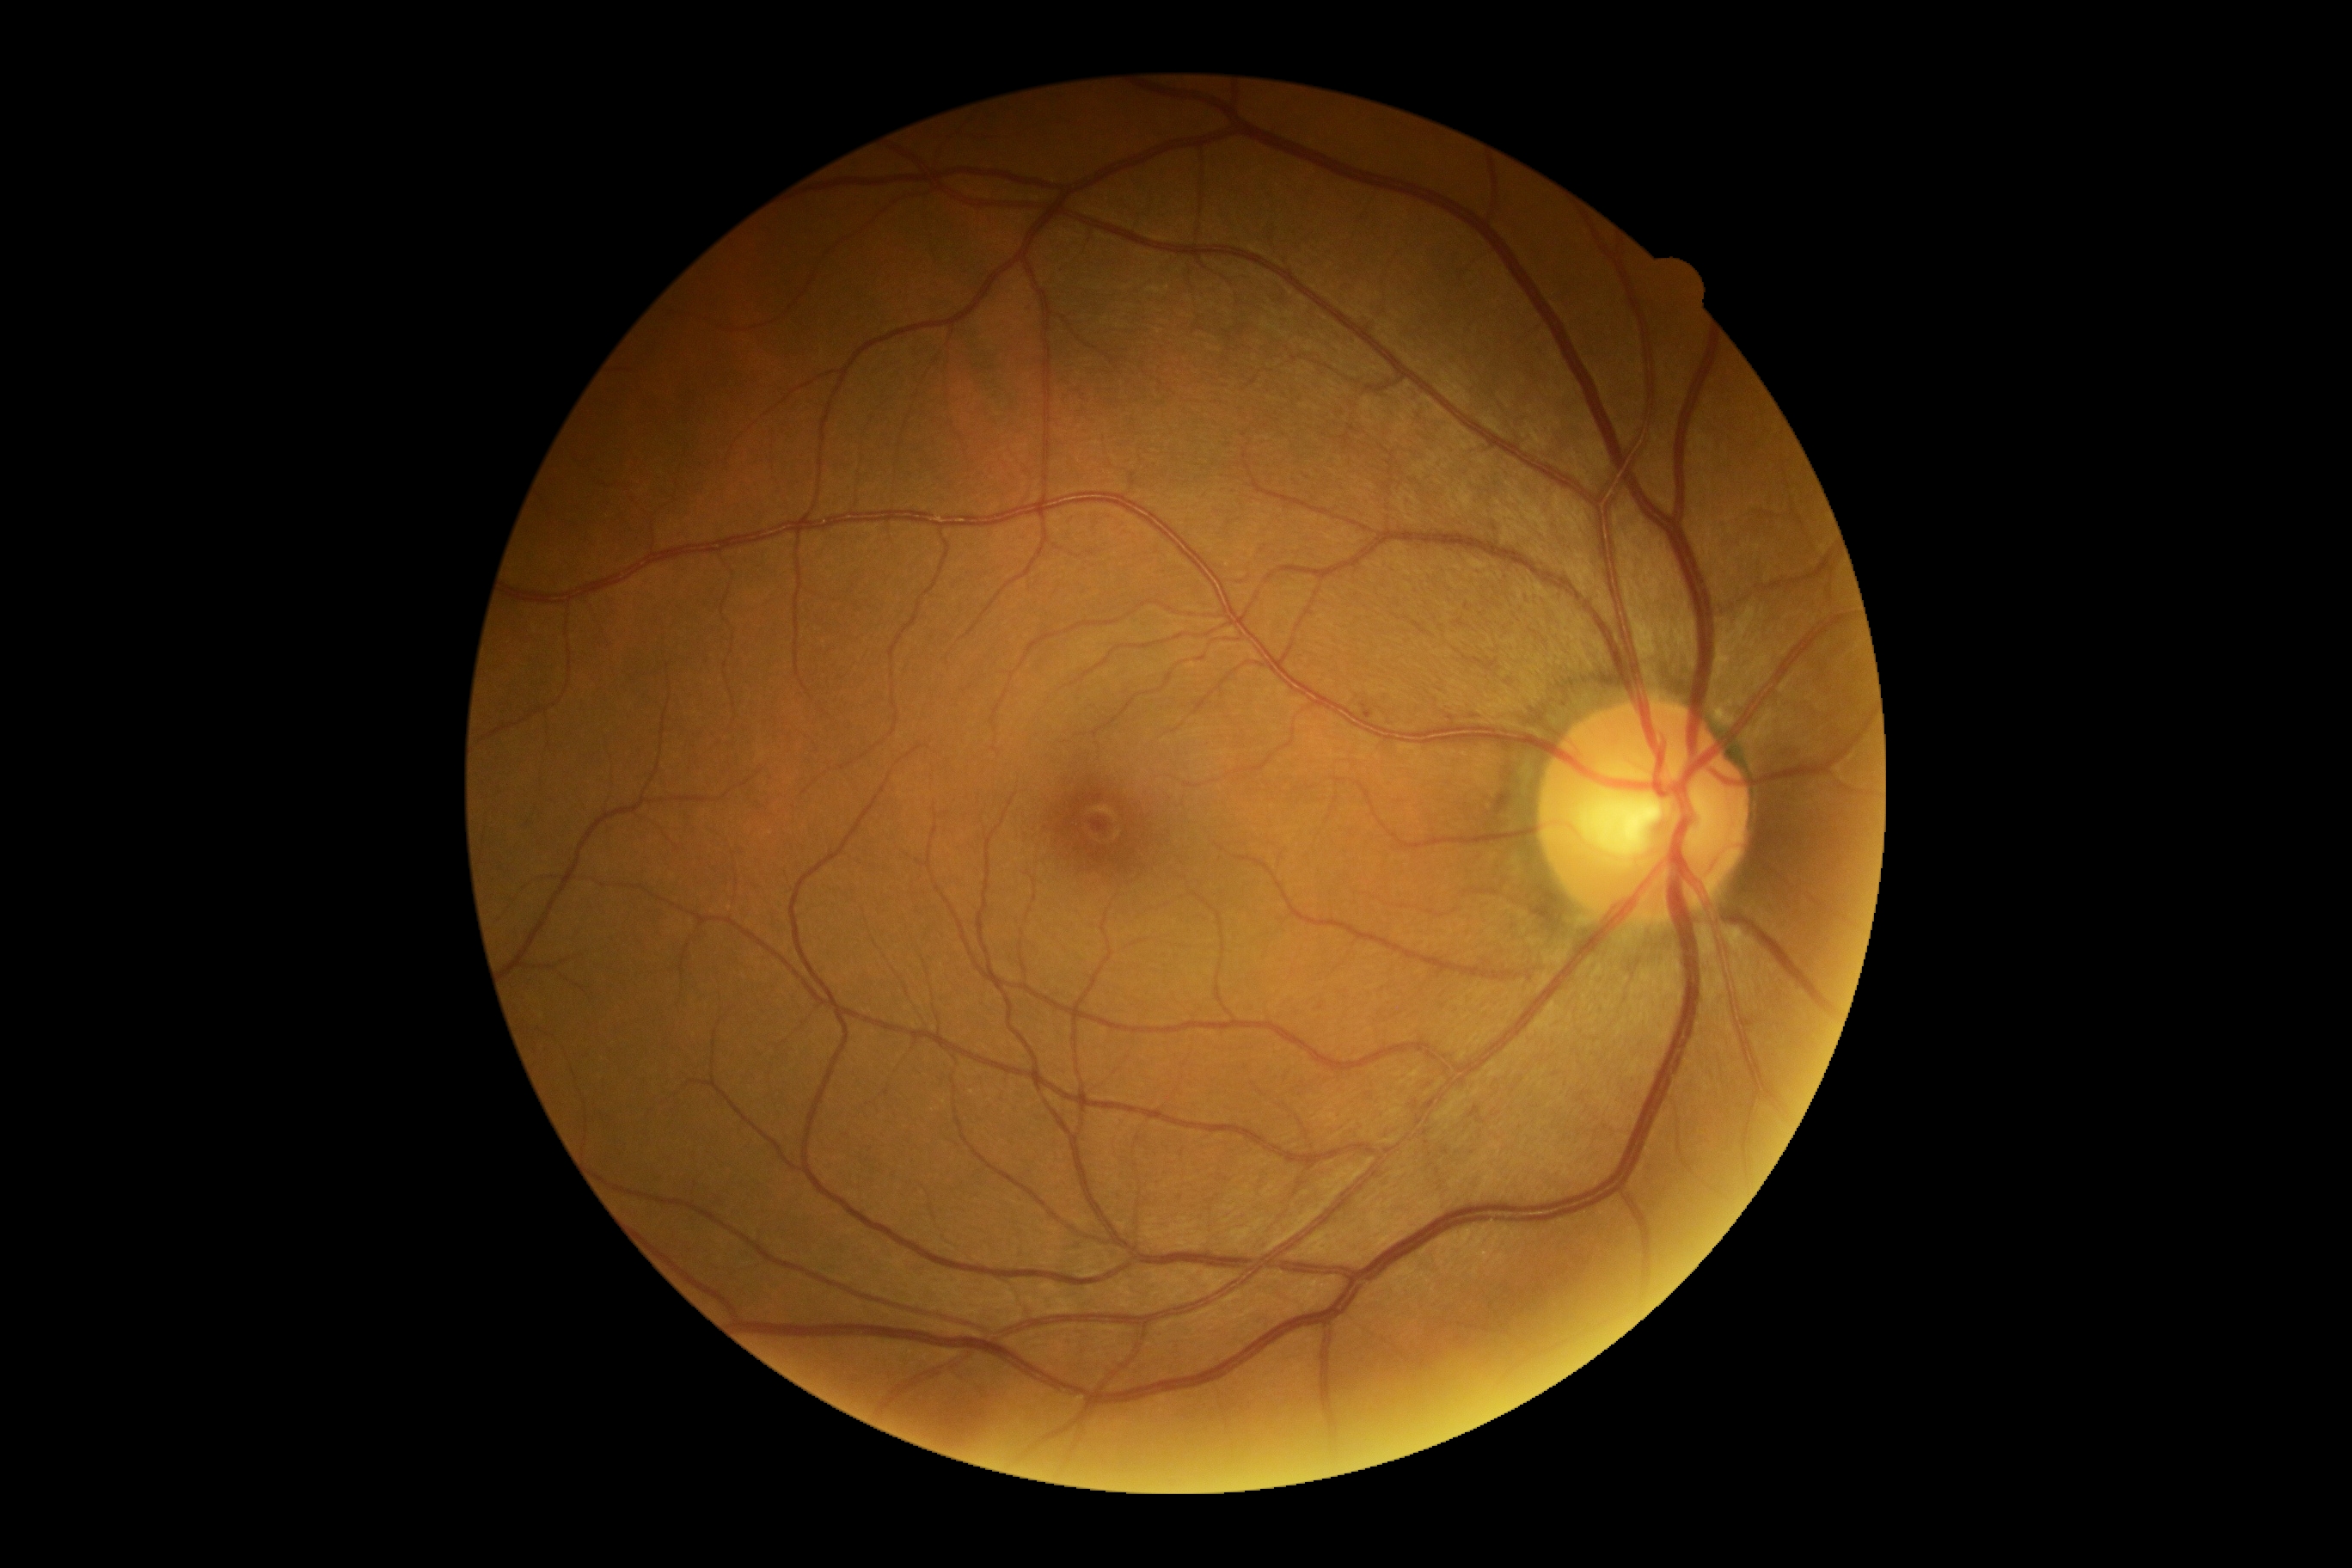
- diabetic retinopathy (DR) — no apparent retinopathy (grade 0) — no visible signs of diabetic retinopathy